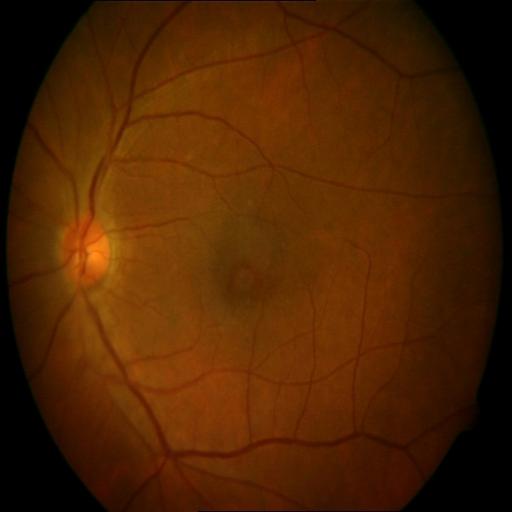

The image shows macular hole.